45-degree field of view, color fundus photograph, 1932x1932: 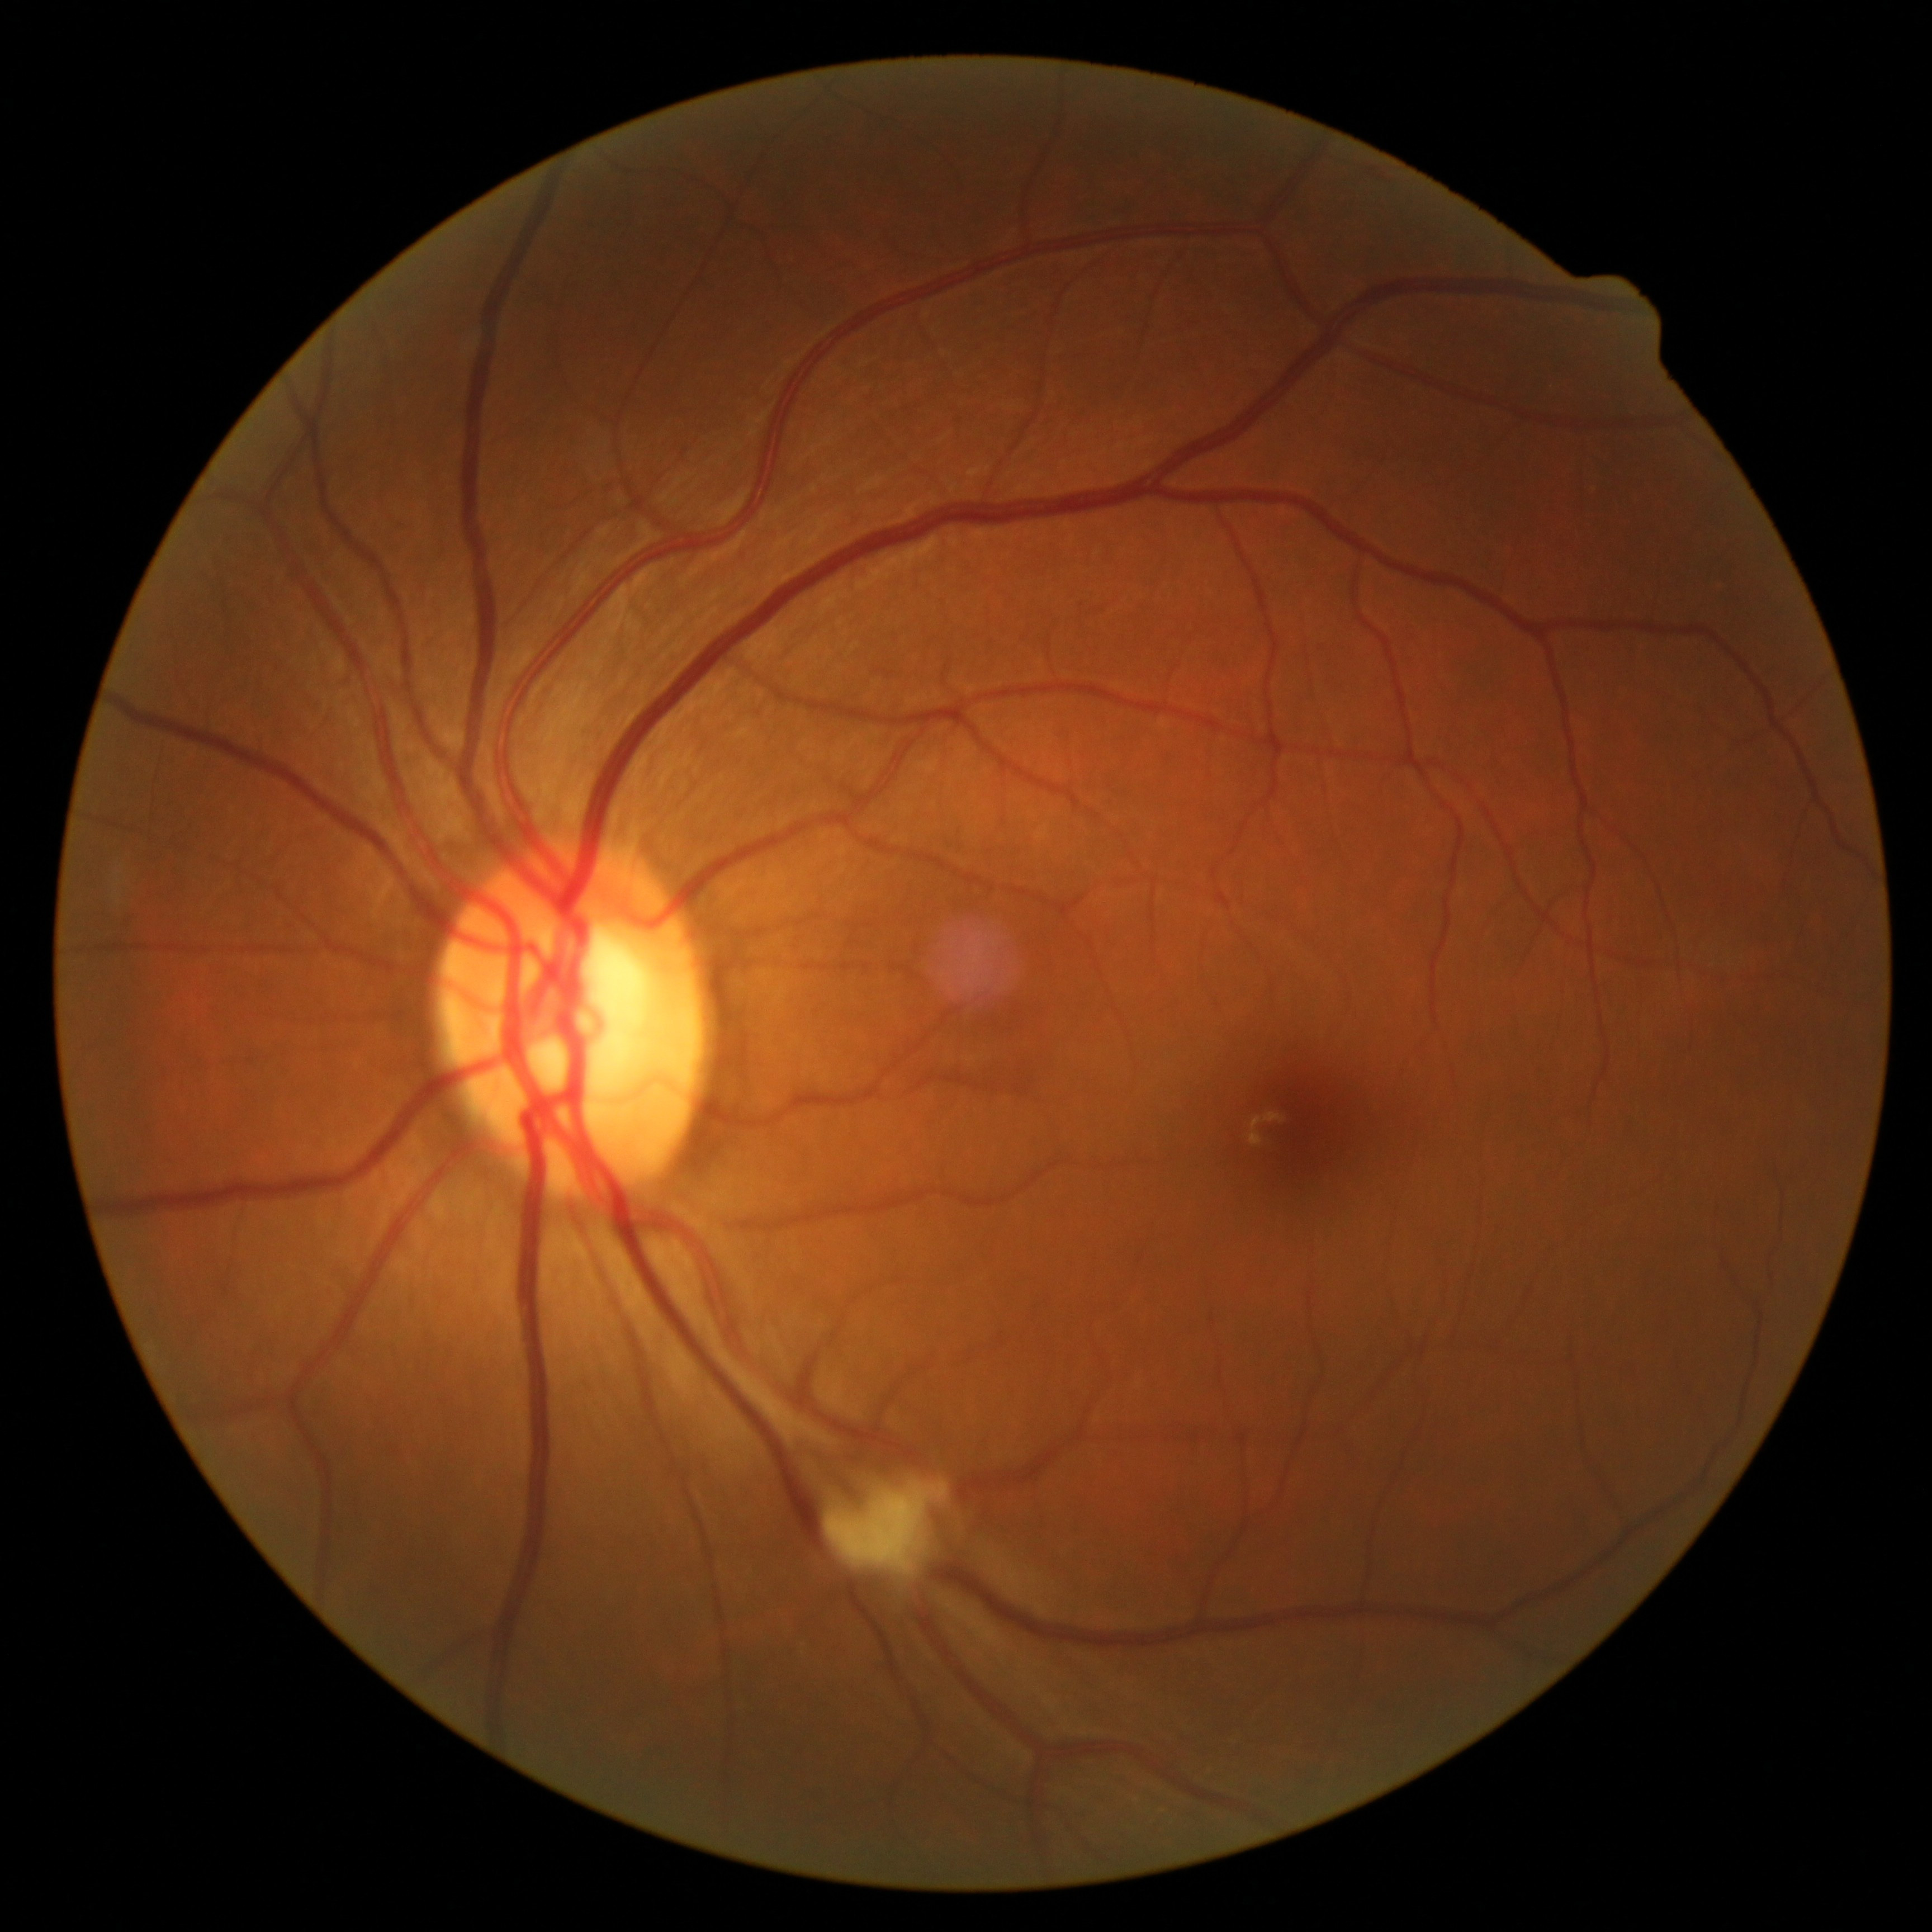
Diabetic retinopathy (DR) is grade 2 (moderate NPDR). DR class: non-proliferative diabetic retinopathy.